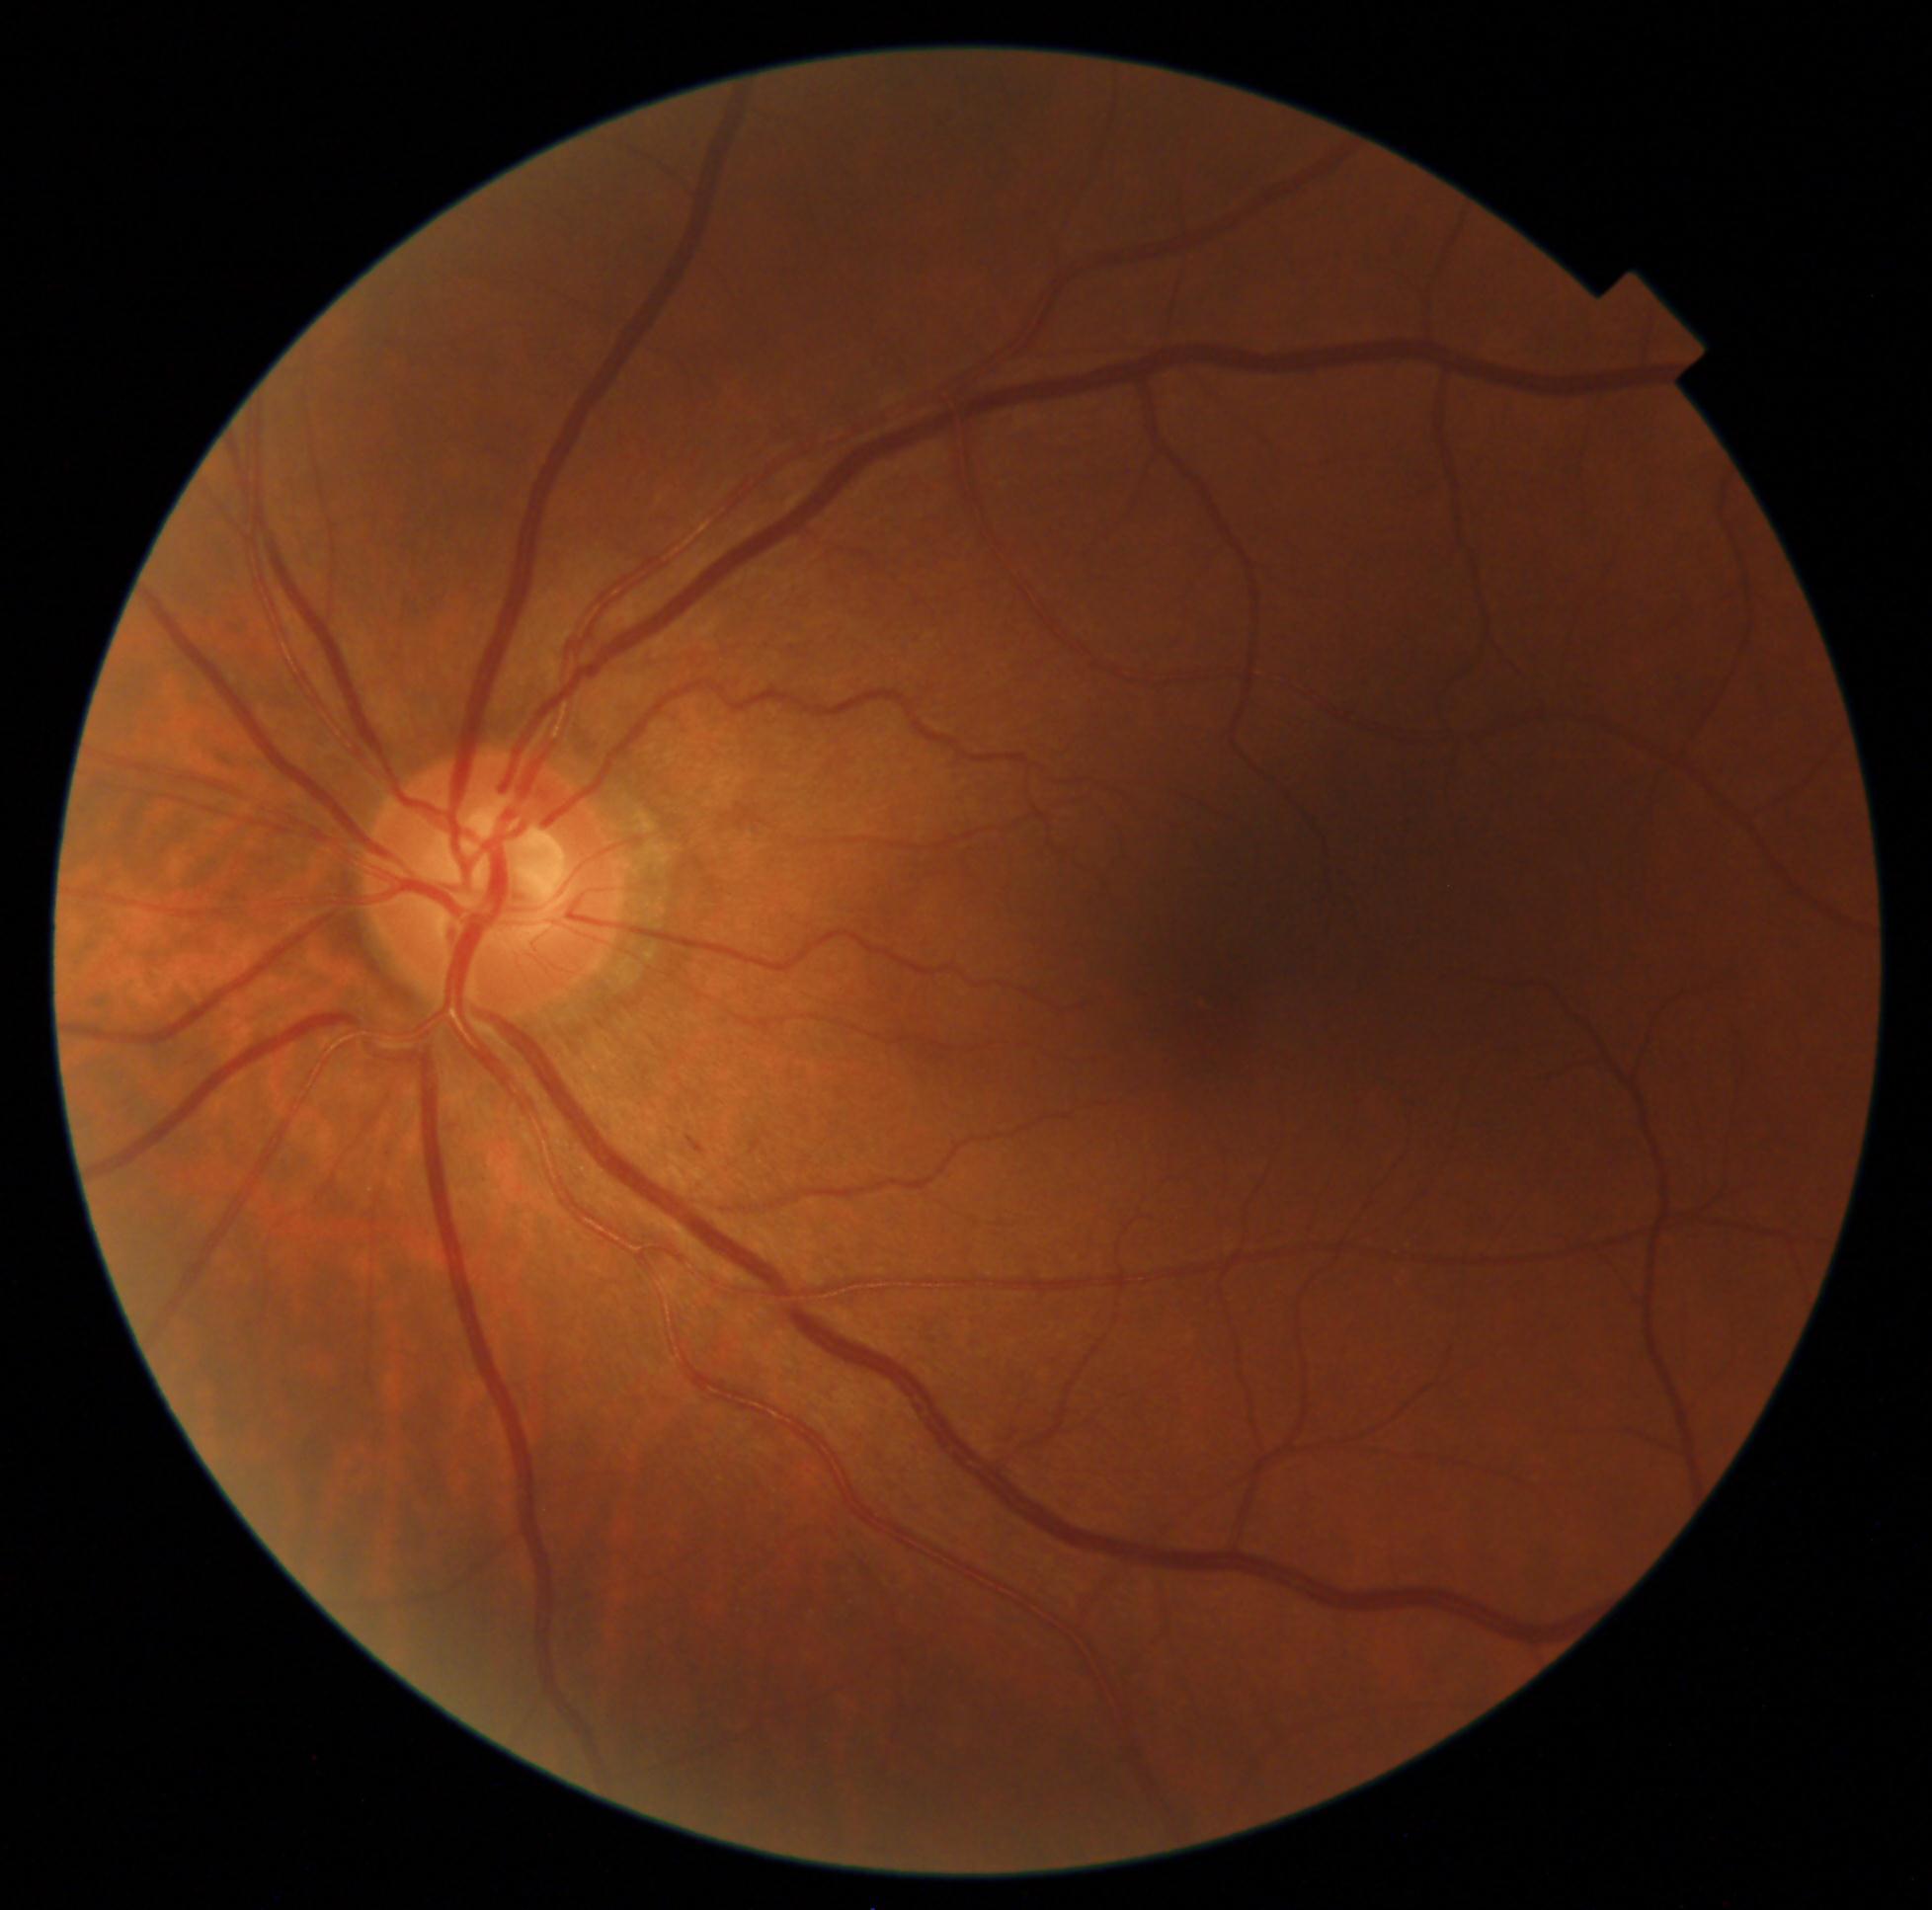 DR grade: 2/4.